Topcon TRC-NW8:
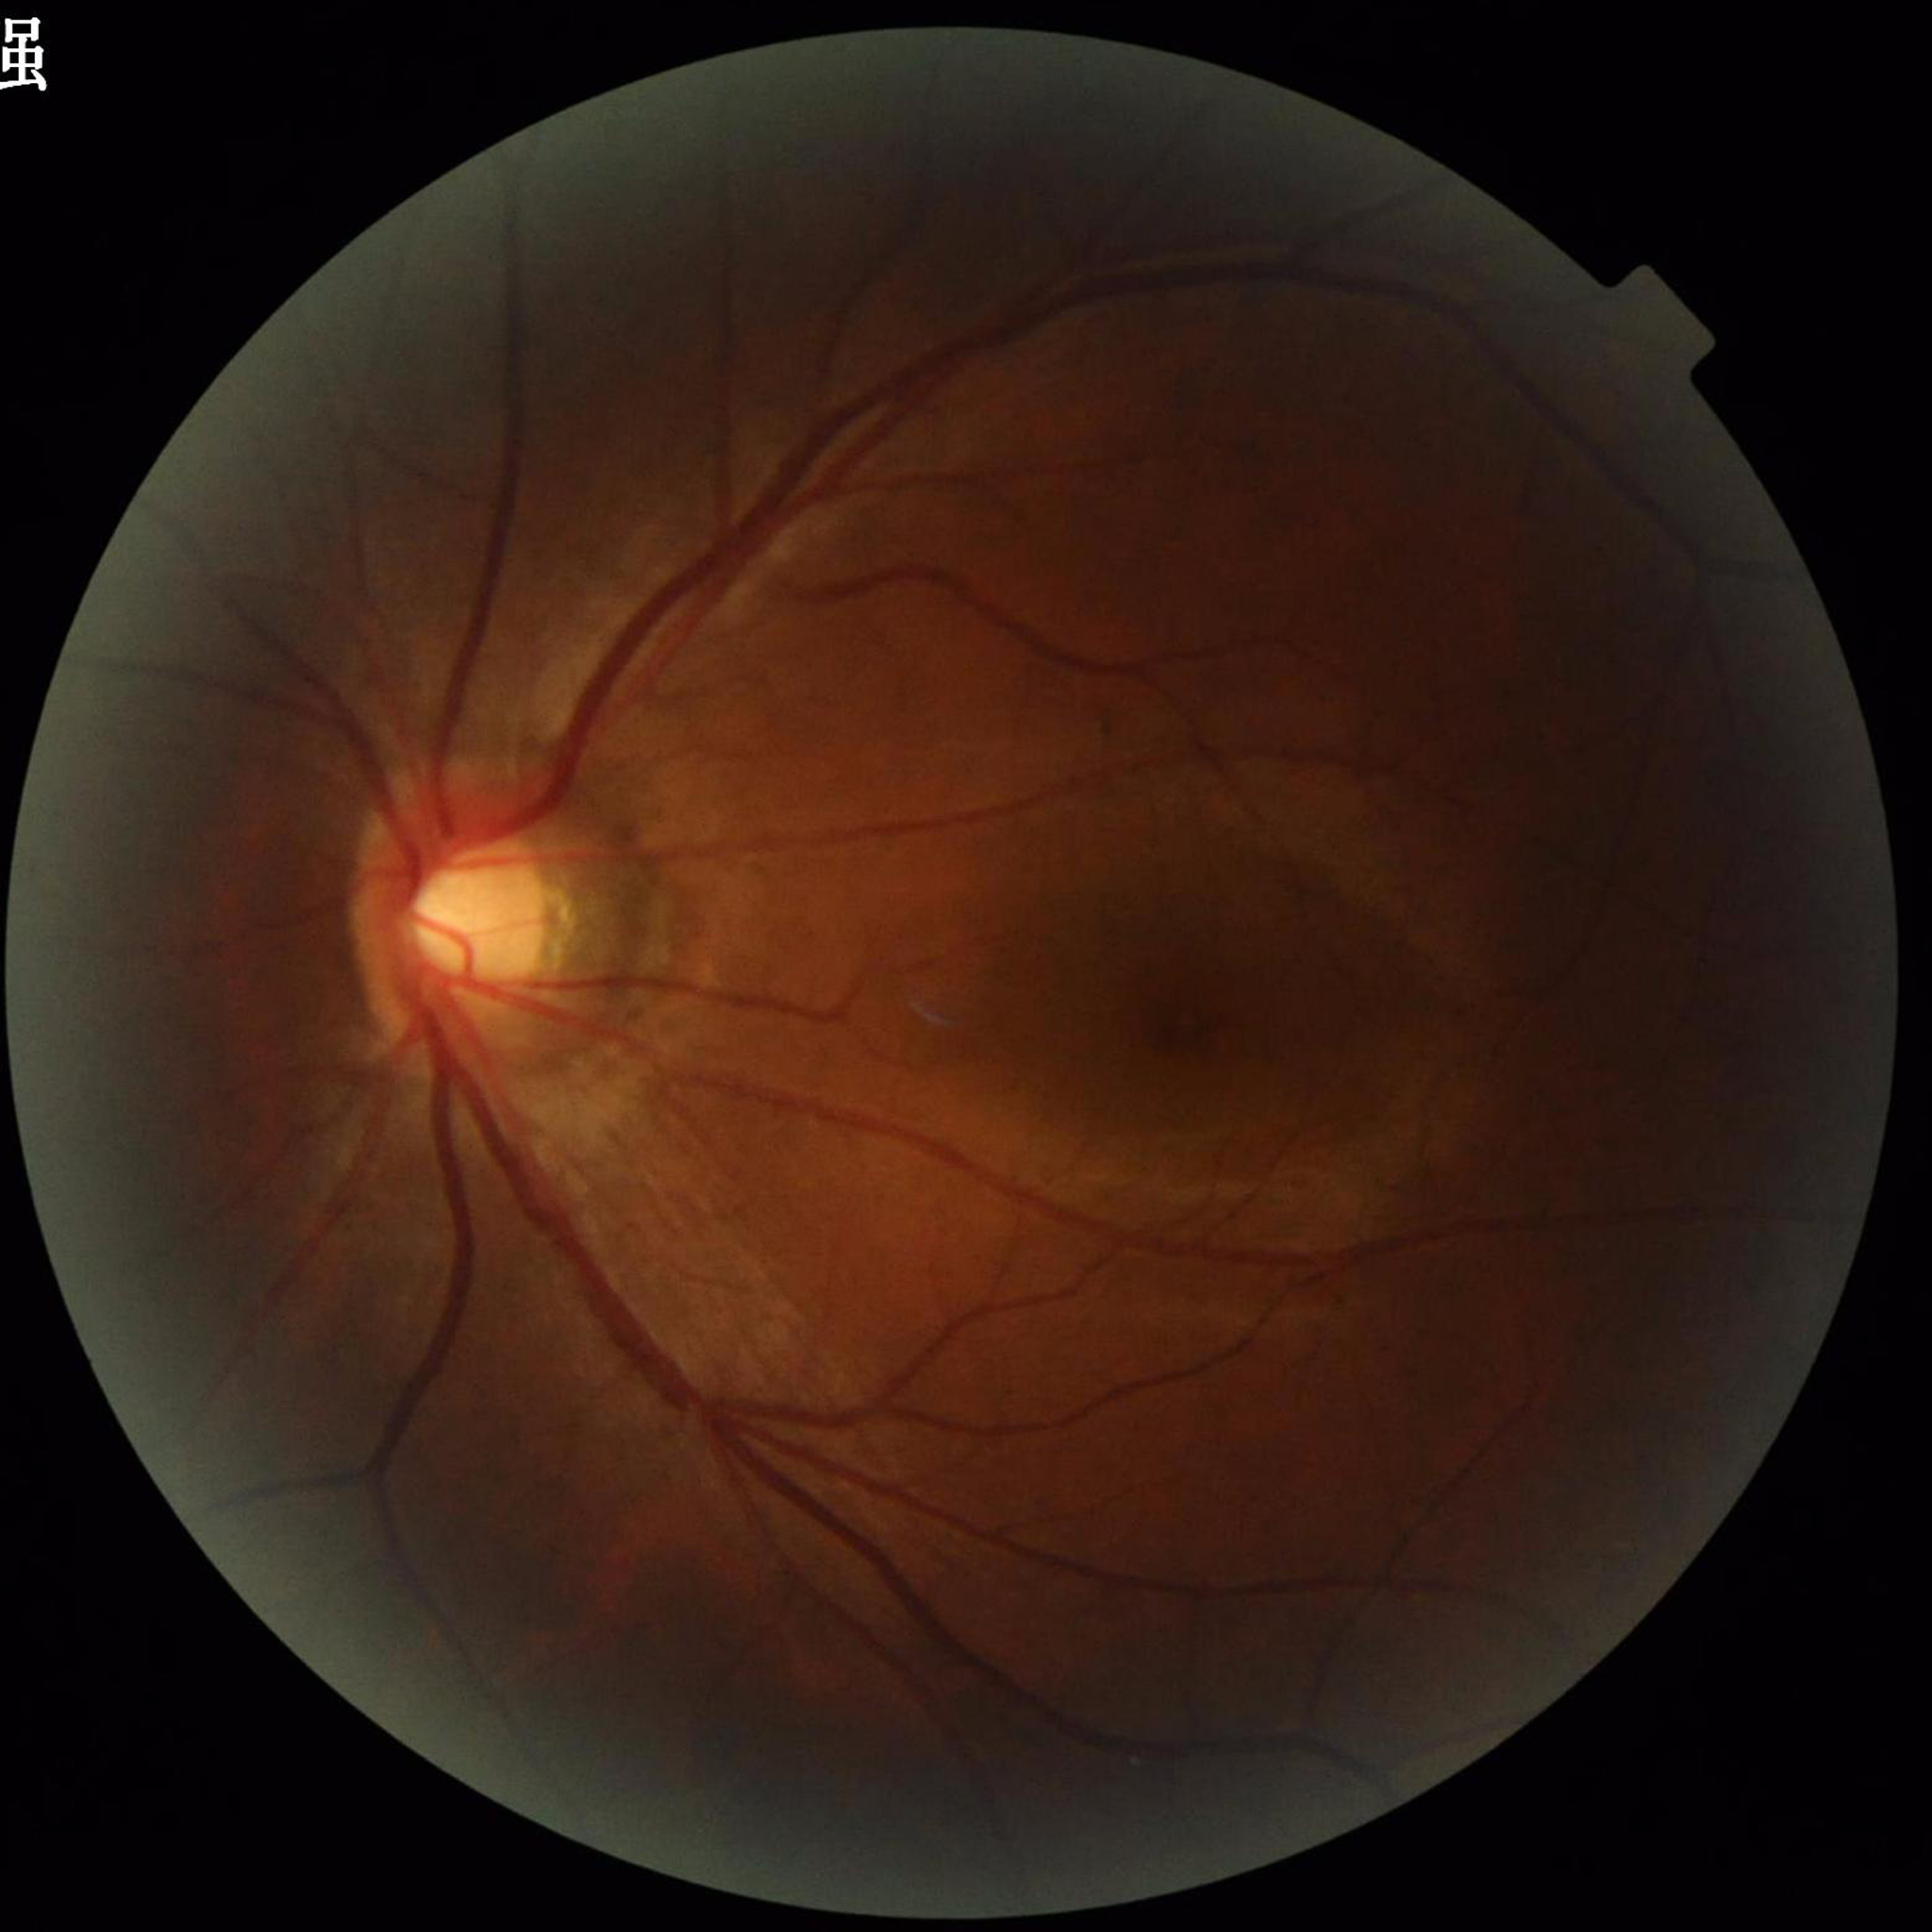 Quality: reduced — illumination/color distortion. The patient was diagnosed with glaucoma.